2352 by 1568 pixels, color fundus image
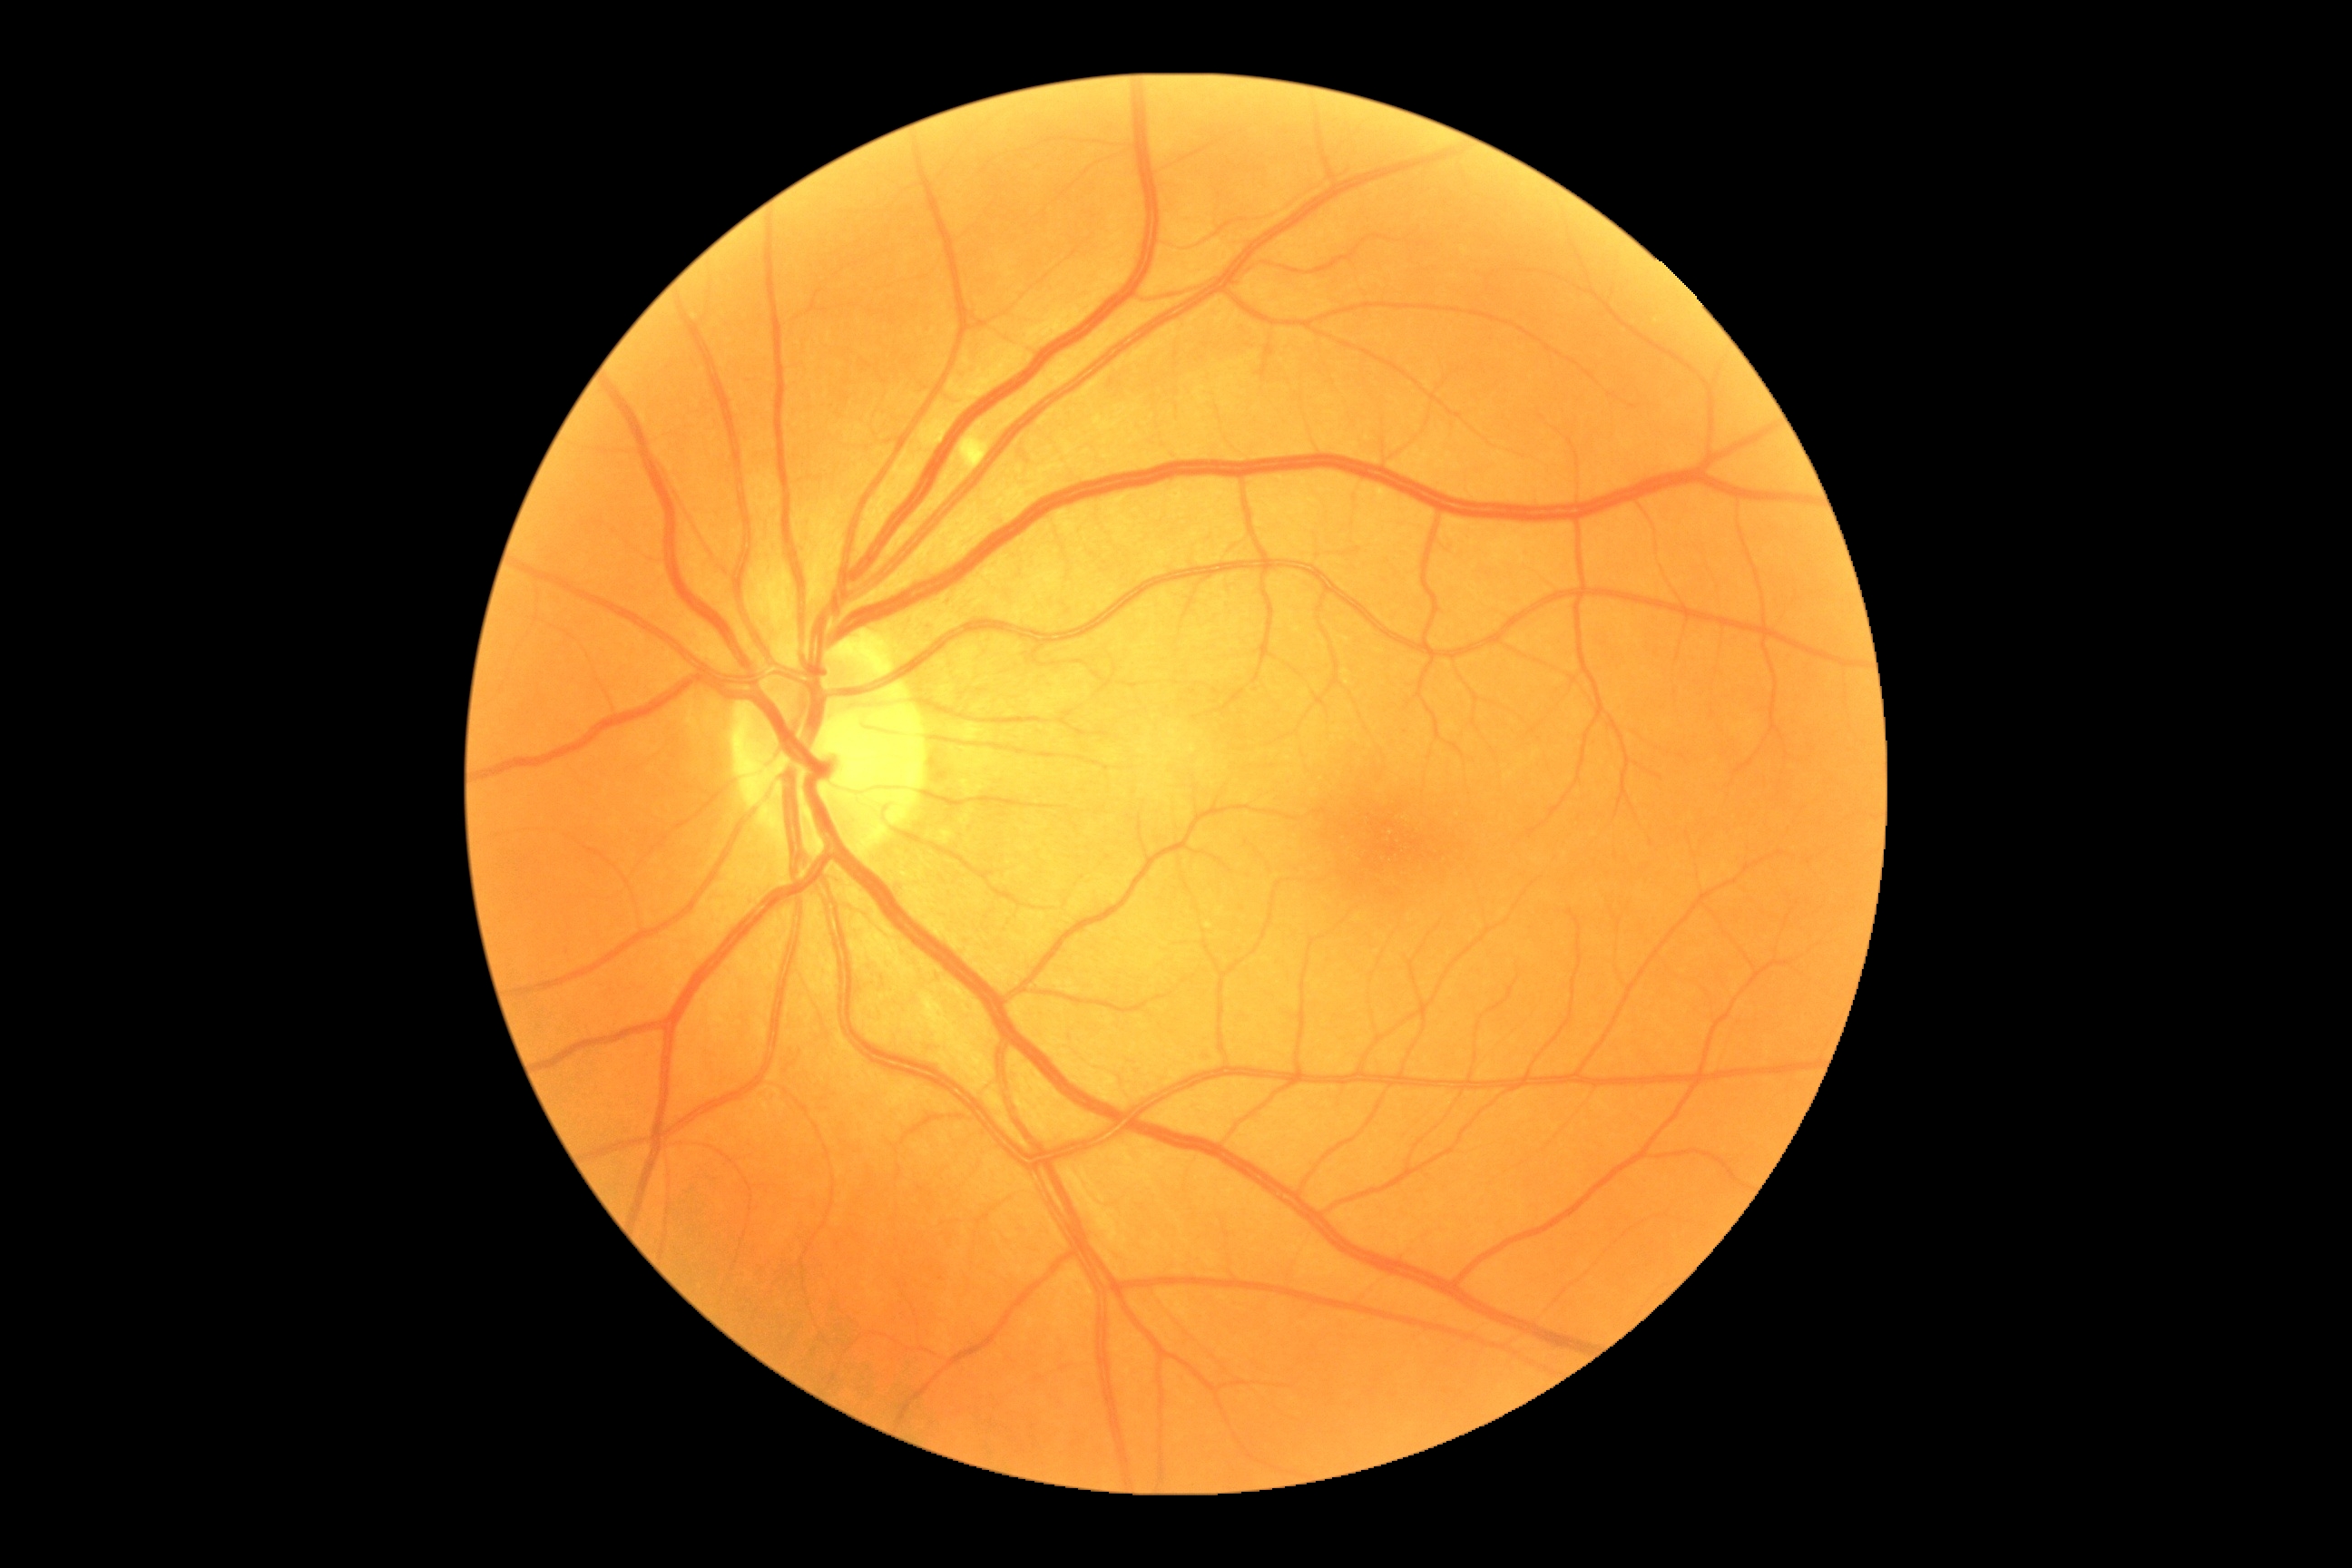

DR class = non-proliferative diabetic retinopathy, diabetic retinopathy severity = grade 2 (moderate NPDR).